Topcon TRC-NW400 · 69 years old · autorefraction: sphere +3.5 D, cylinder -2 D, axis 82° · man · IOP by applanation tonometry: 20 mmHg · fundus photo · axial length (AL): 21.28 mm:
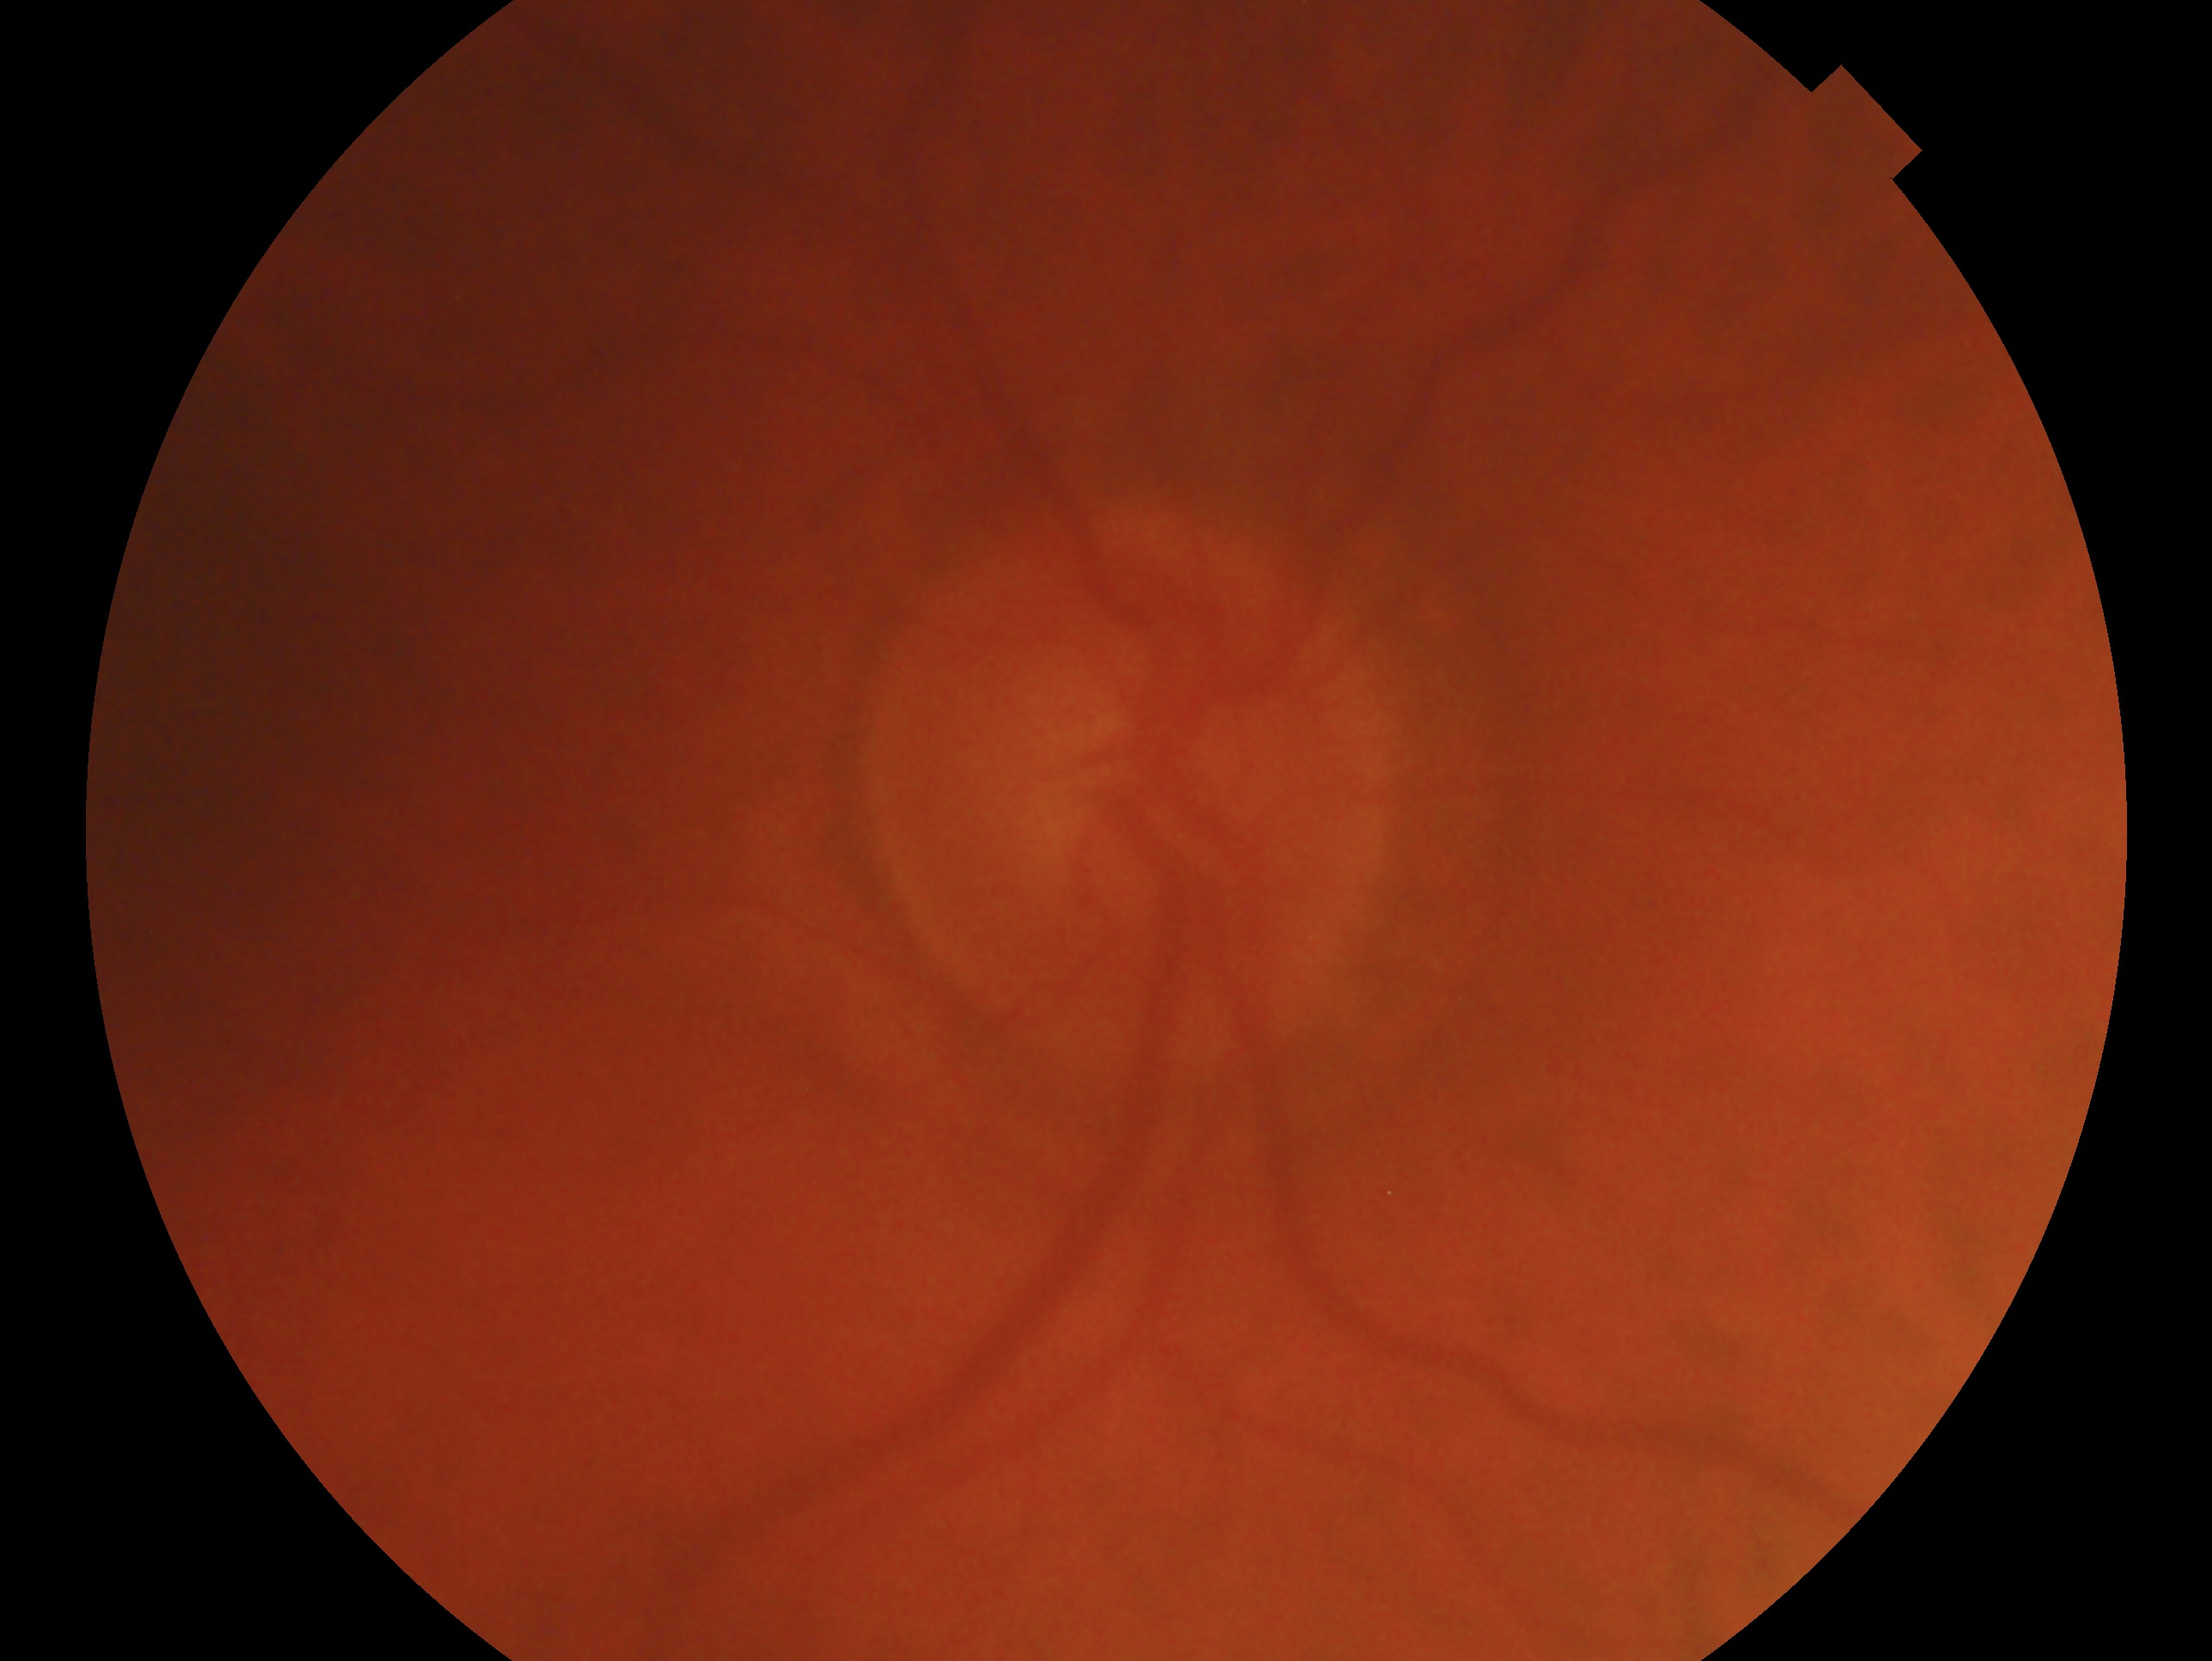
{
  "glaucoma_dx": "suspicious for glaucoma — risk factors or equivocal findings for glaucoma without a confirmed diagnosis",
  "eye": "right eye"
}